Image size 1240x1240. Infant wide-field fundus photograph. Camera: Phoenix ICON (100° FOV).
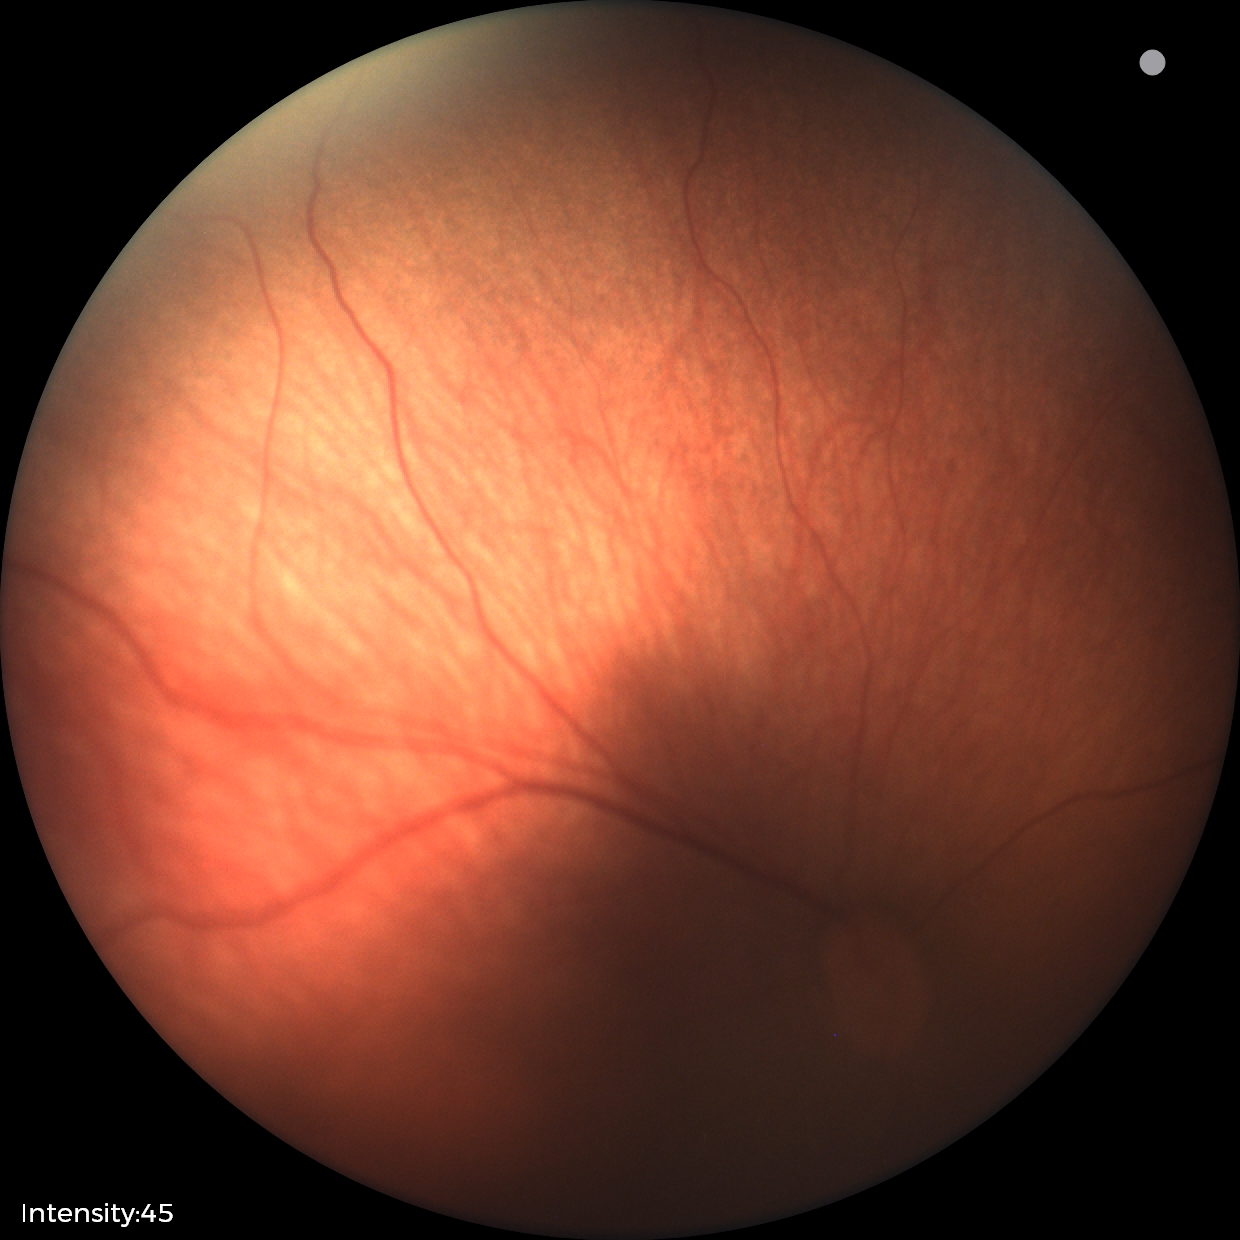 Examination diagnosed as retinopathy of prematurity (ROP) stage 1.
No plus disease.